CFP: 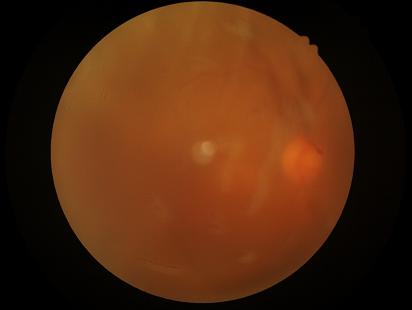 Quality assessment:
- illumination: poor
- sharpness: blurry
- overall: inadequate
- contrast: reduced